45-degree field of view; image size 848x848
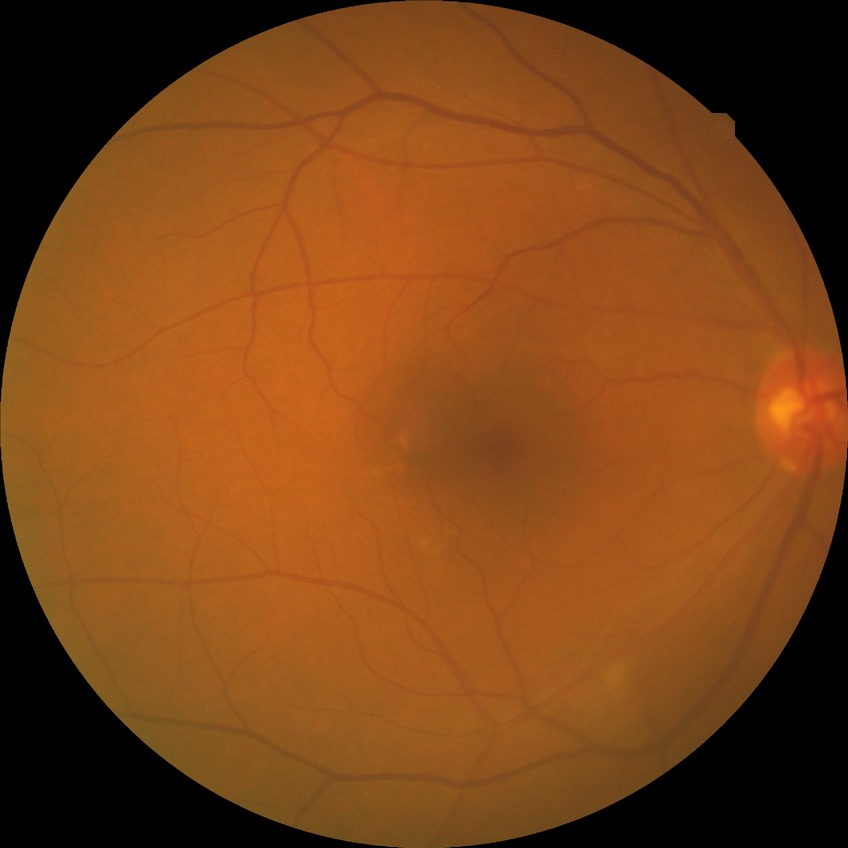 Davis grade@NDR; DR impression@negative for DR.